2048x1536px. 45-degree field of view: 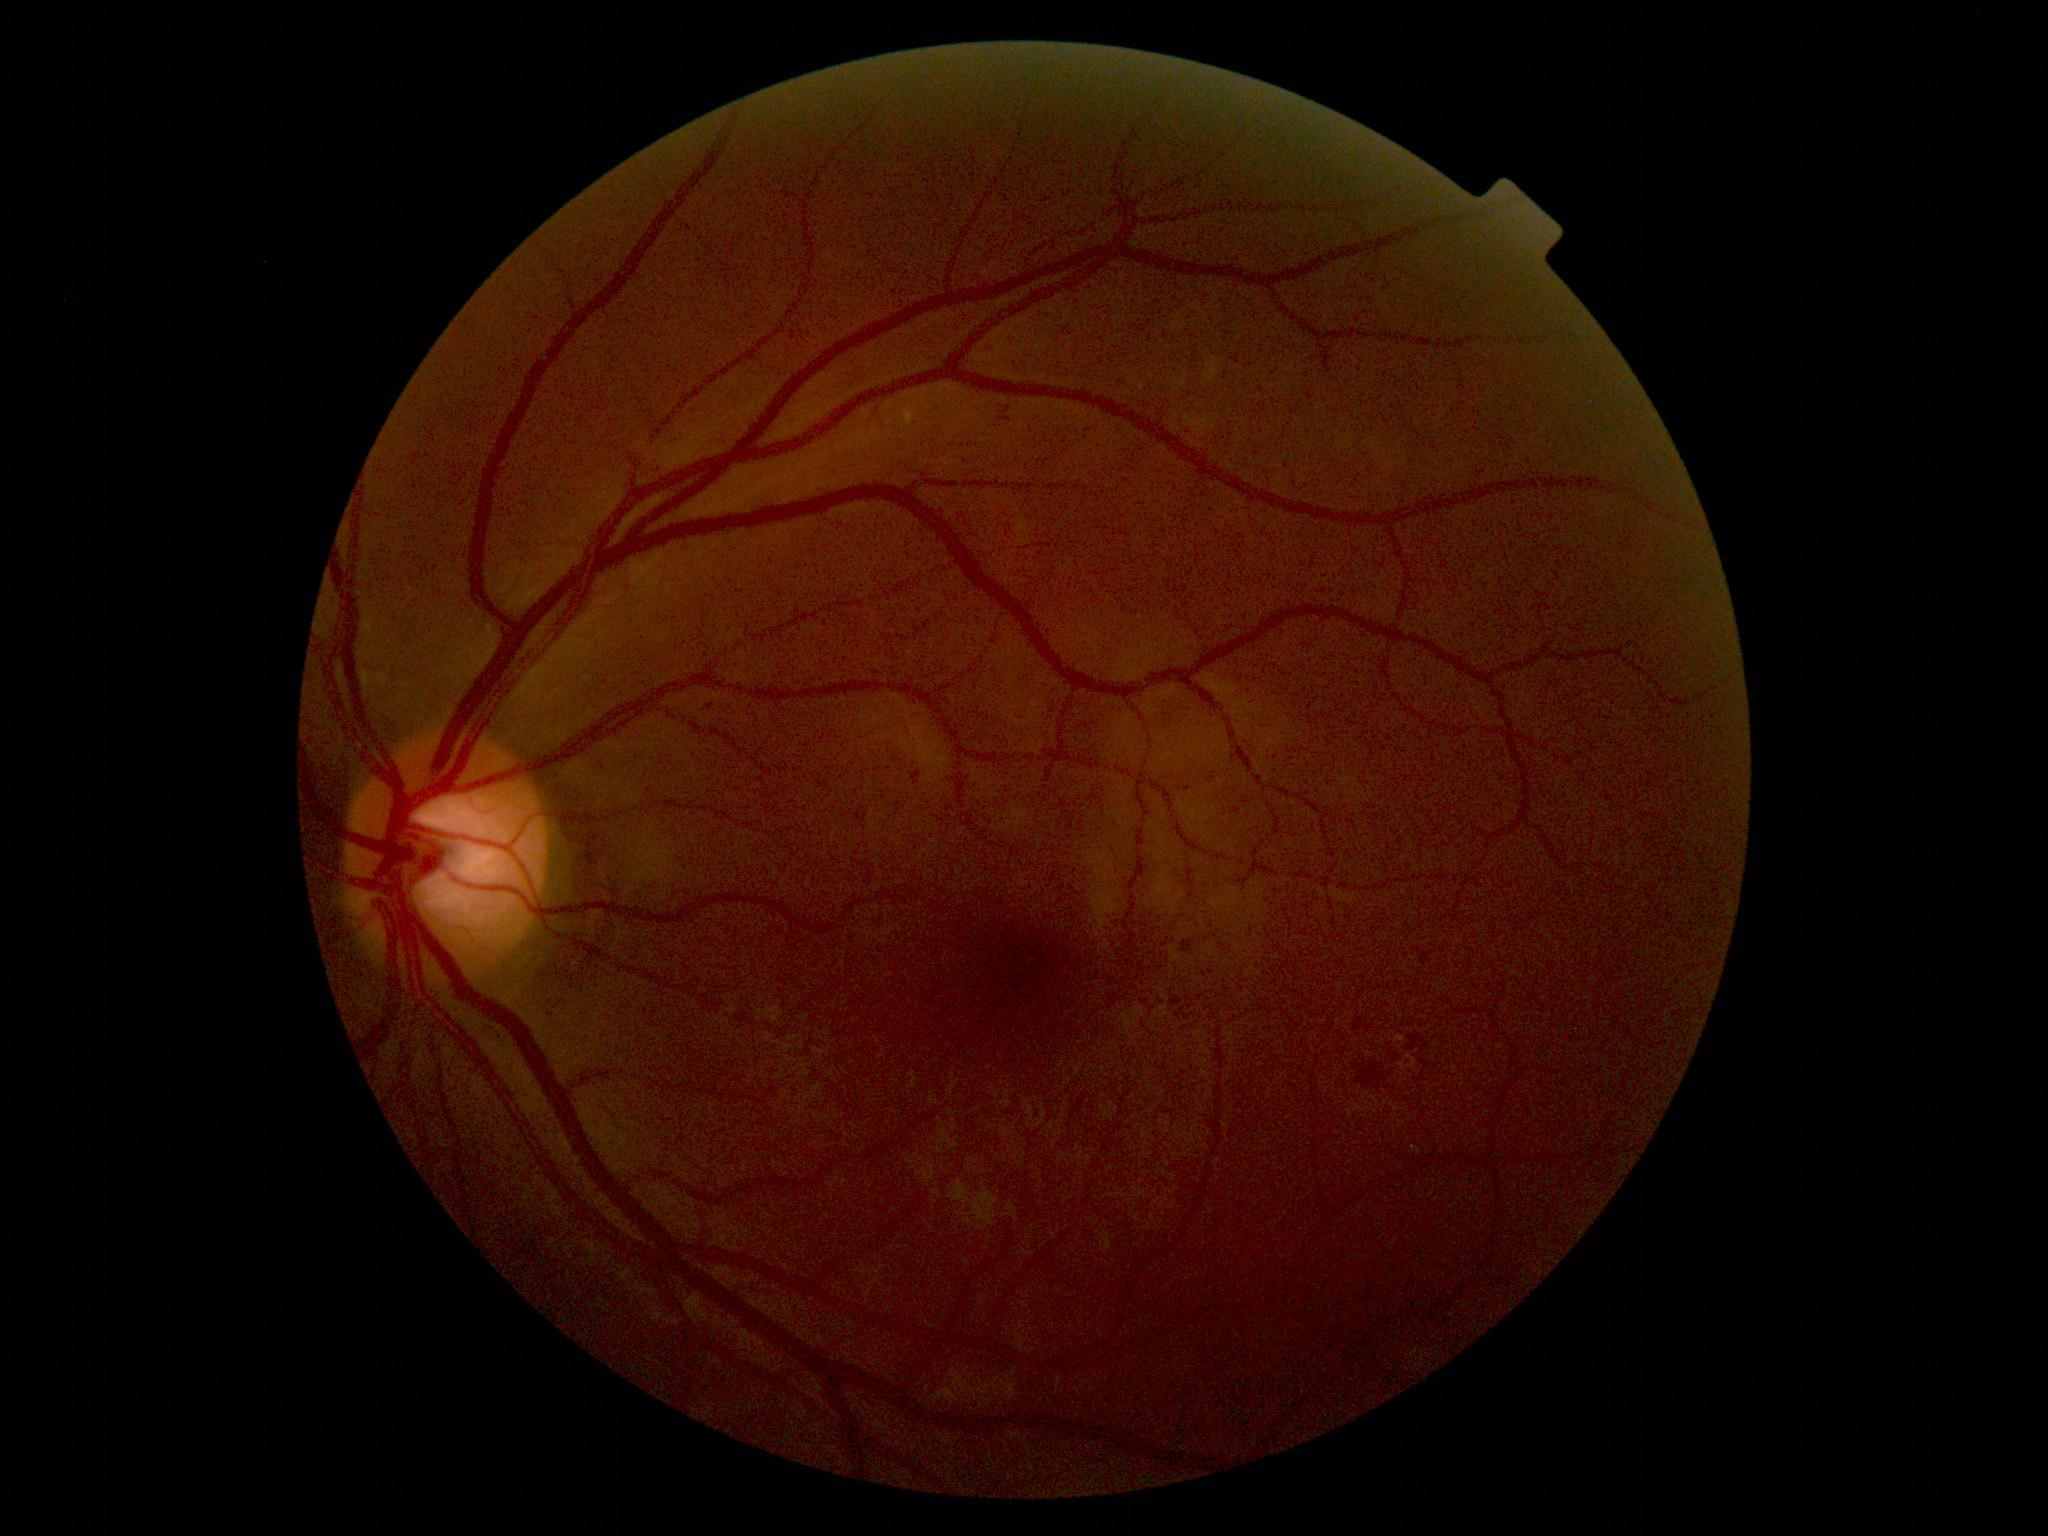

diabetic retinopathy grade: 2 (moderate NPDR)
DR class: non-proliferative diabetic retinopathy